848 by 848 pixels:
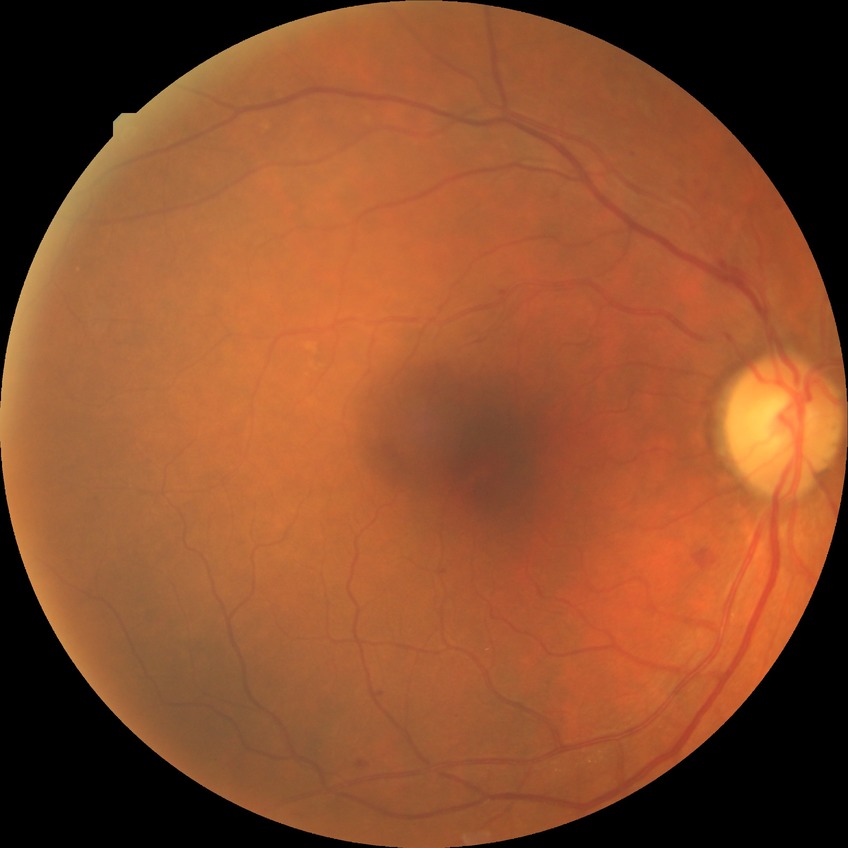

diabetic retinopathy (DR)@SDR (simple diabetic retinopathy).